CFP; camera: Kowa VX-10α:
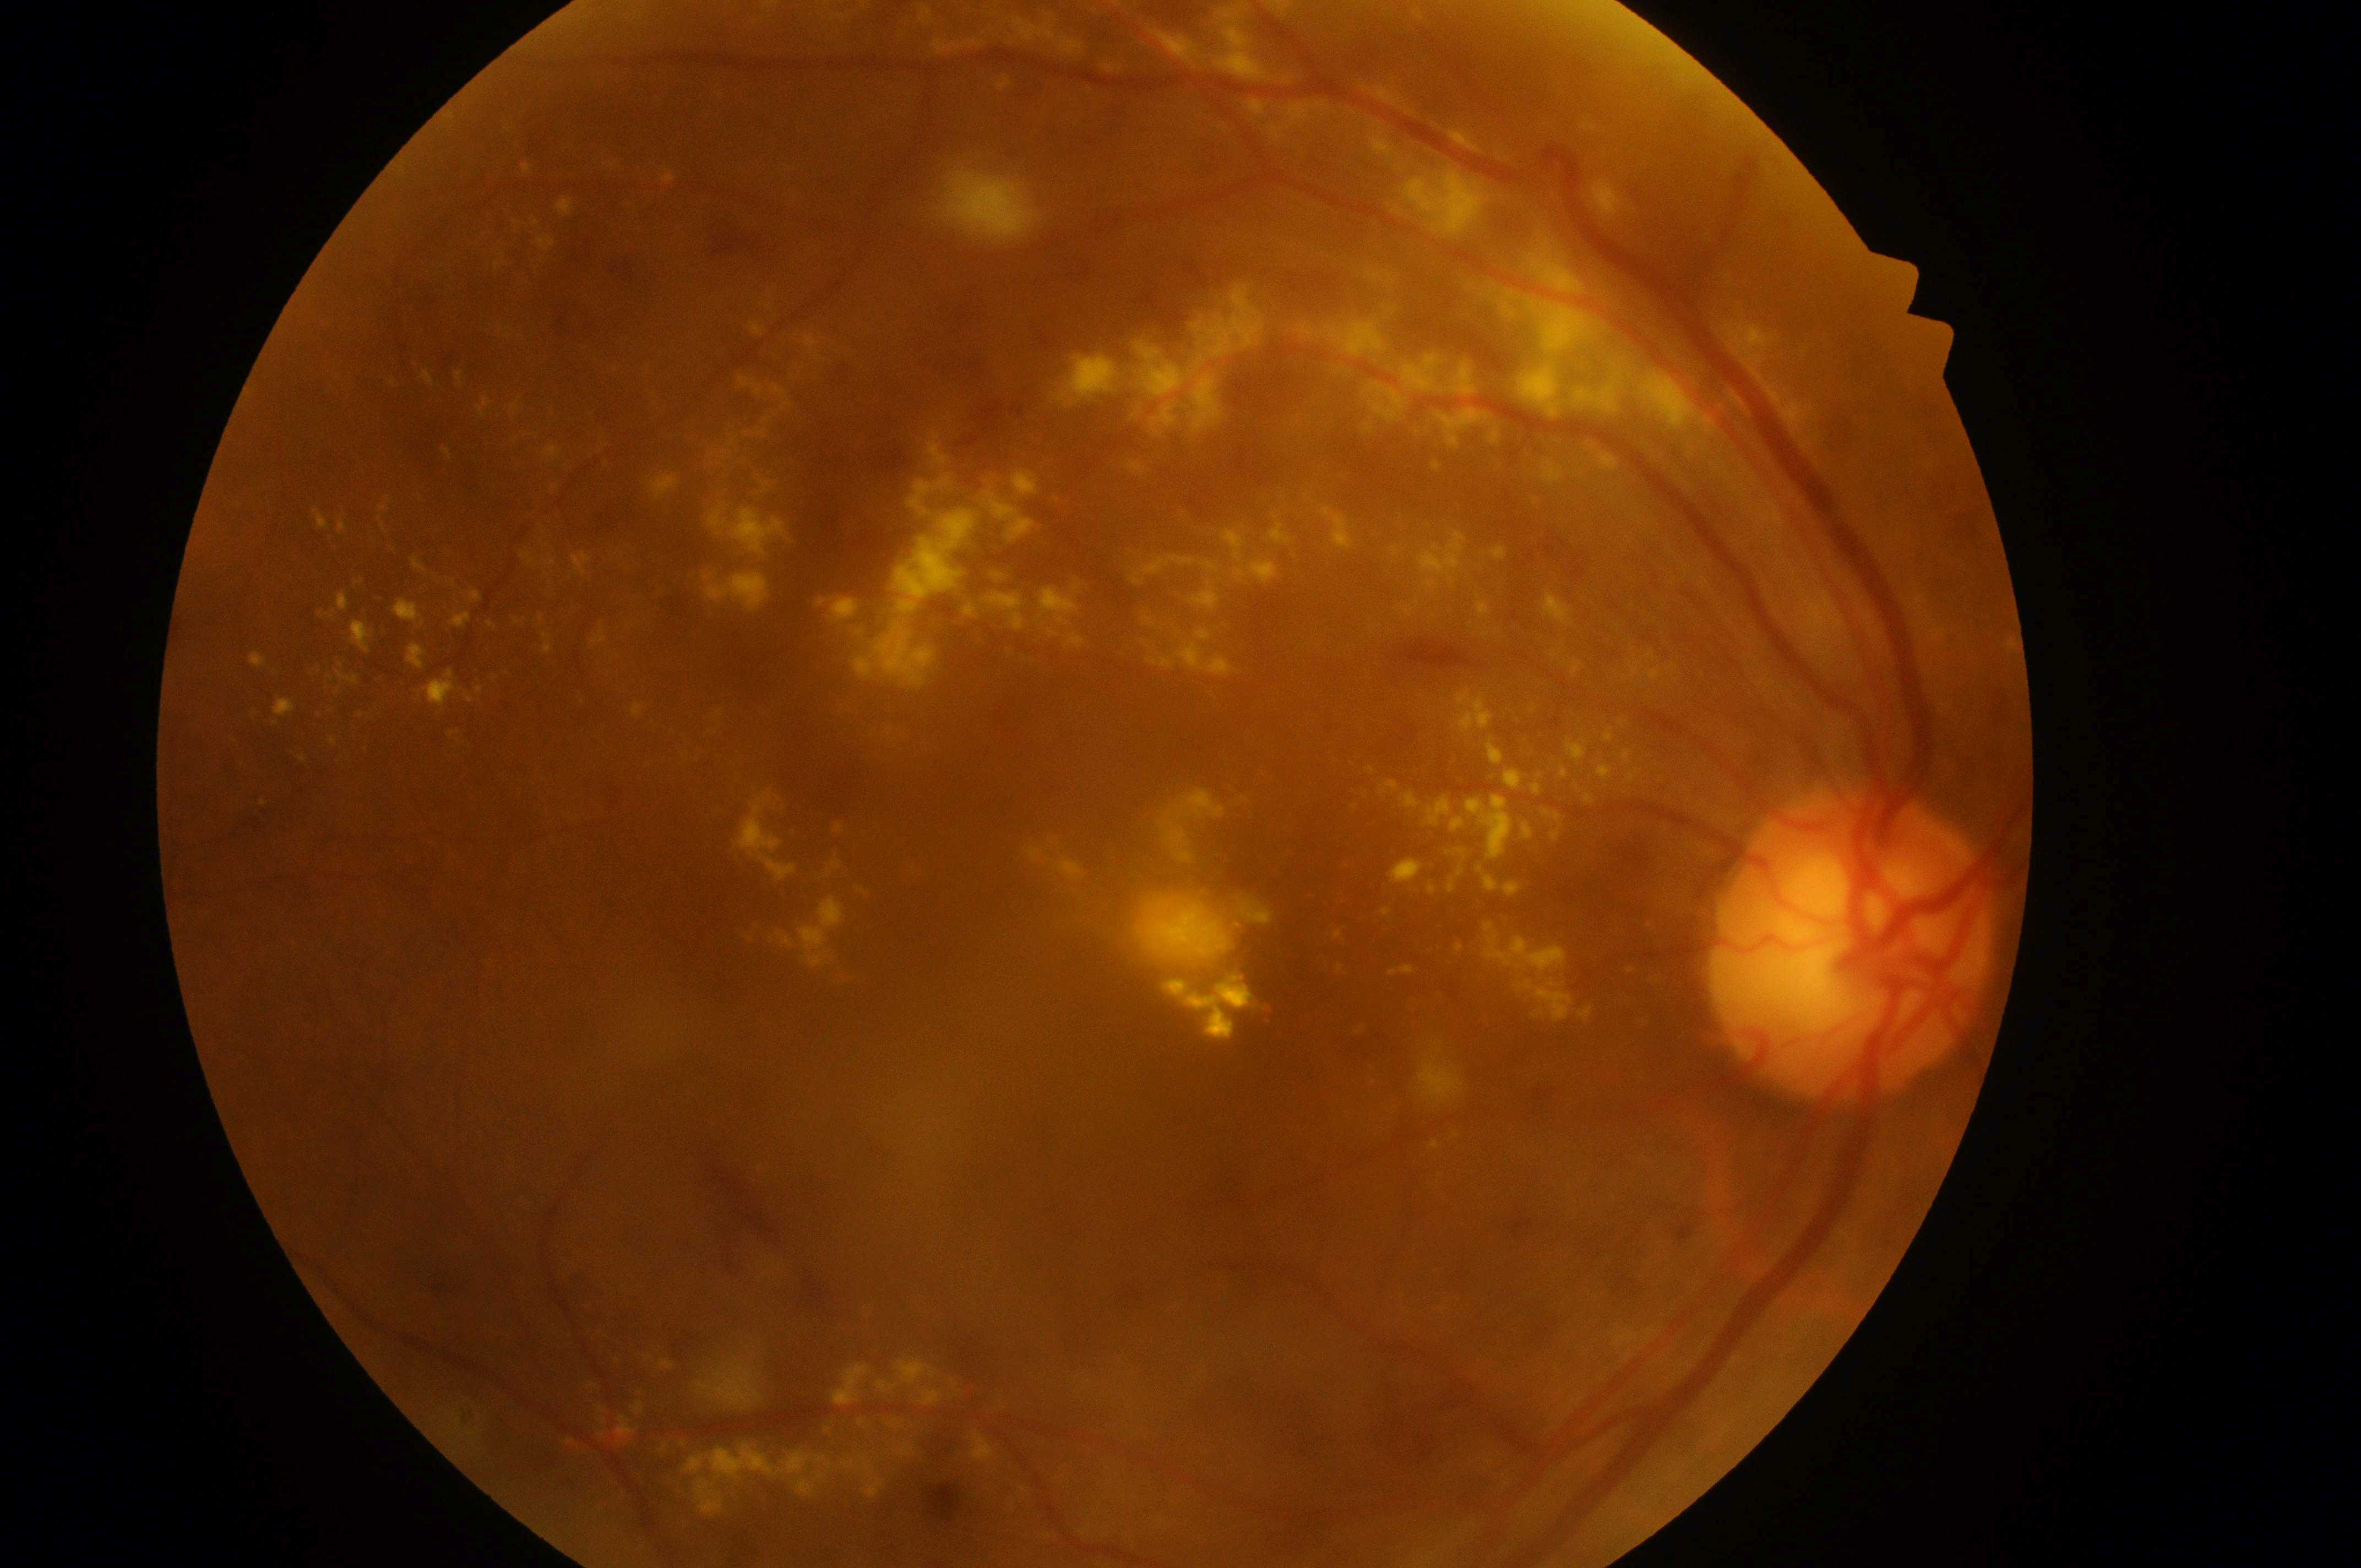
DR severity: 3.
Optic disc: (x=1854, y=963).
Macular center located at (x=1043, y=977).
DME risk: 2/2.
This is the right eye.